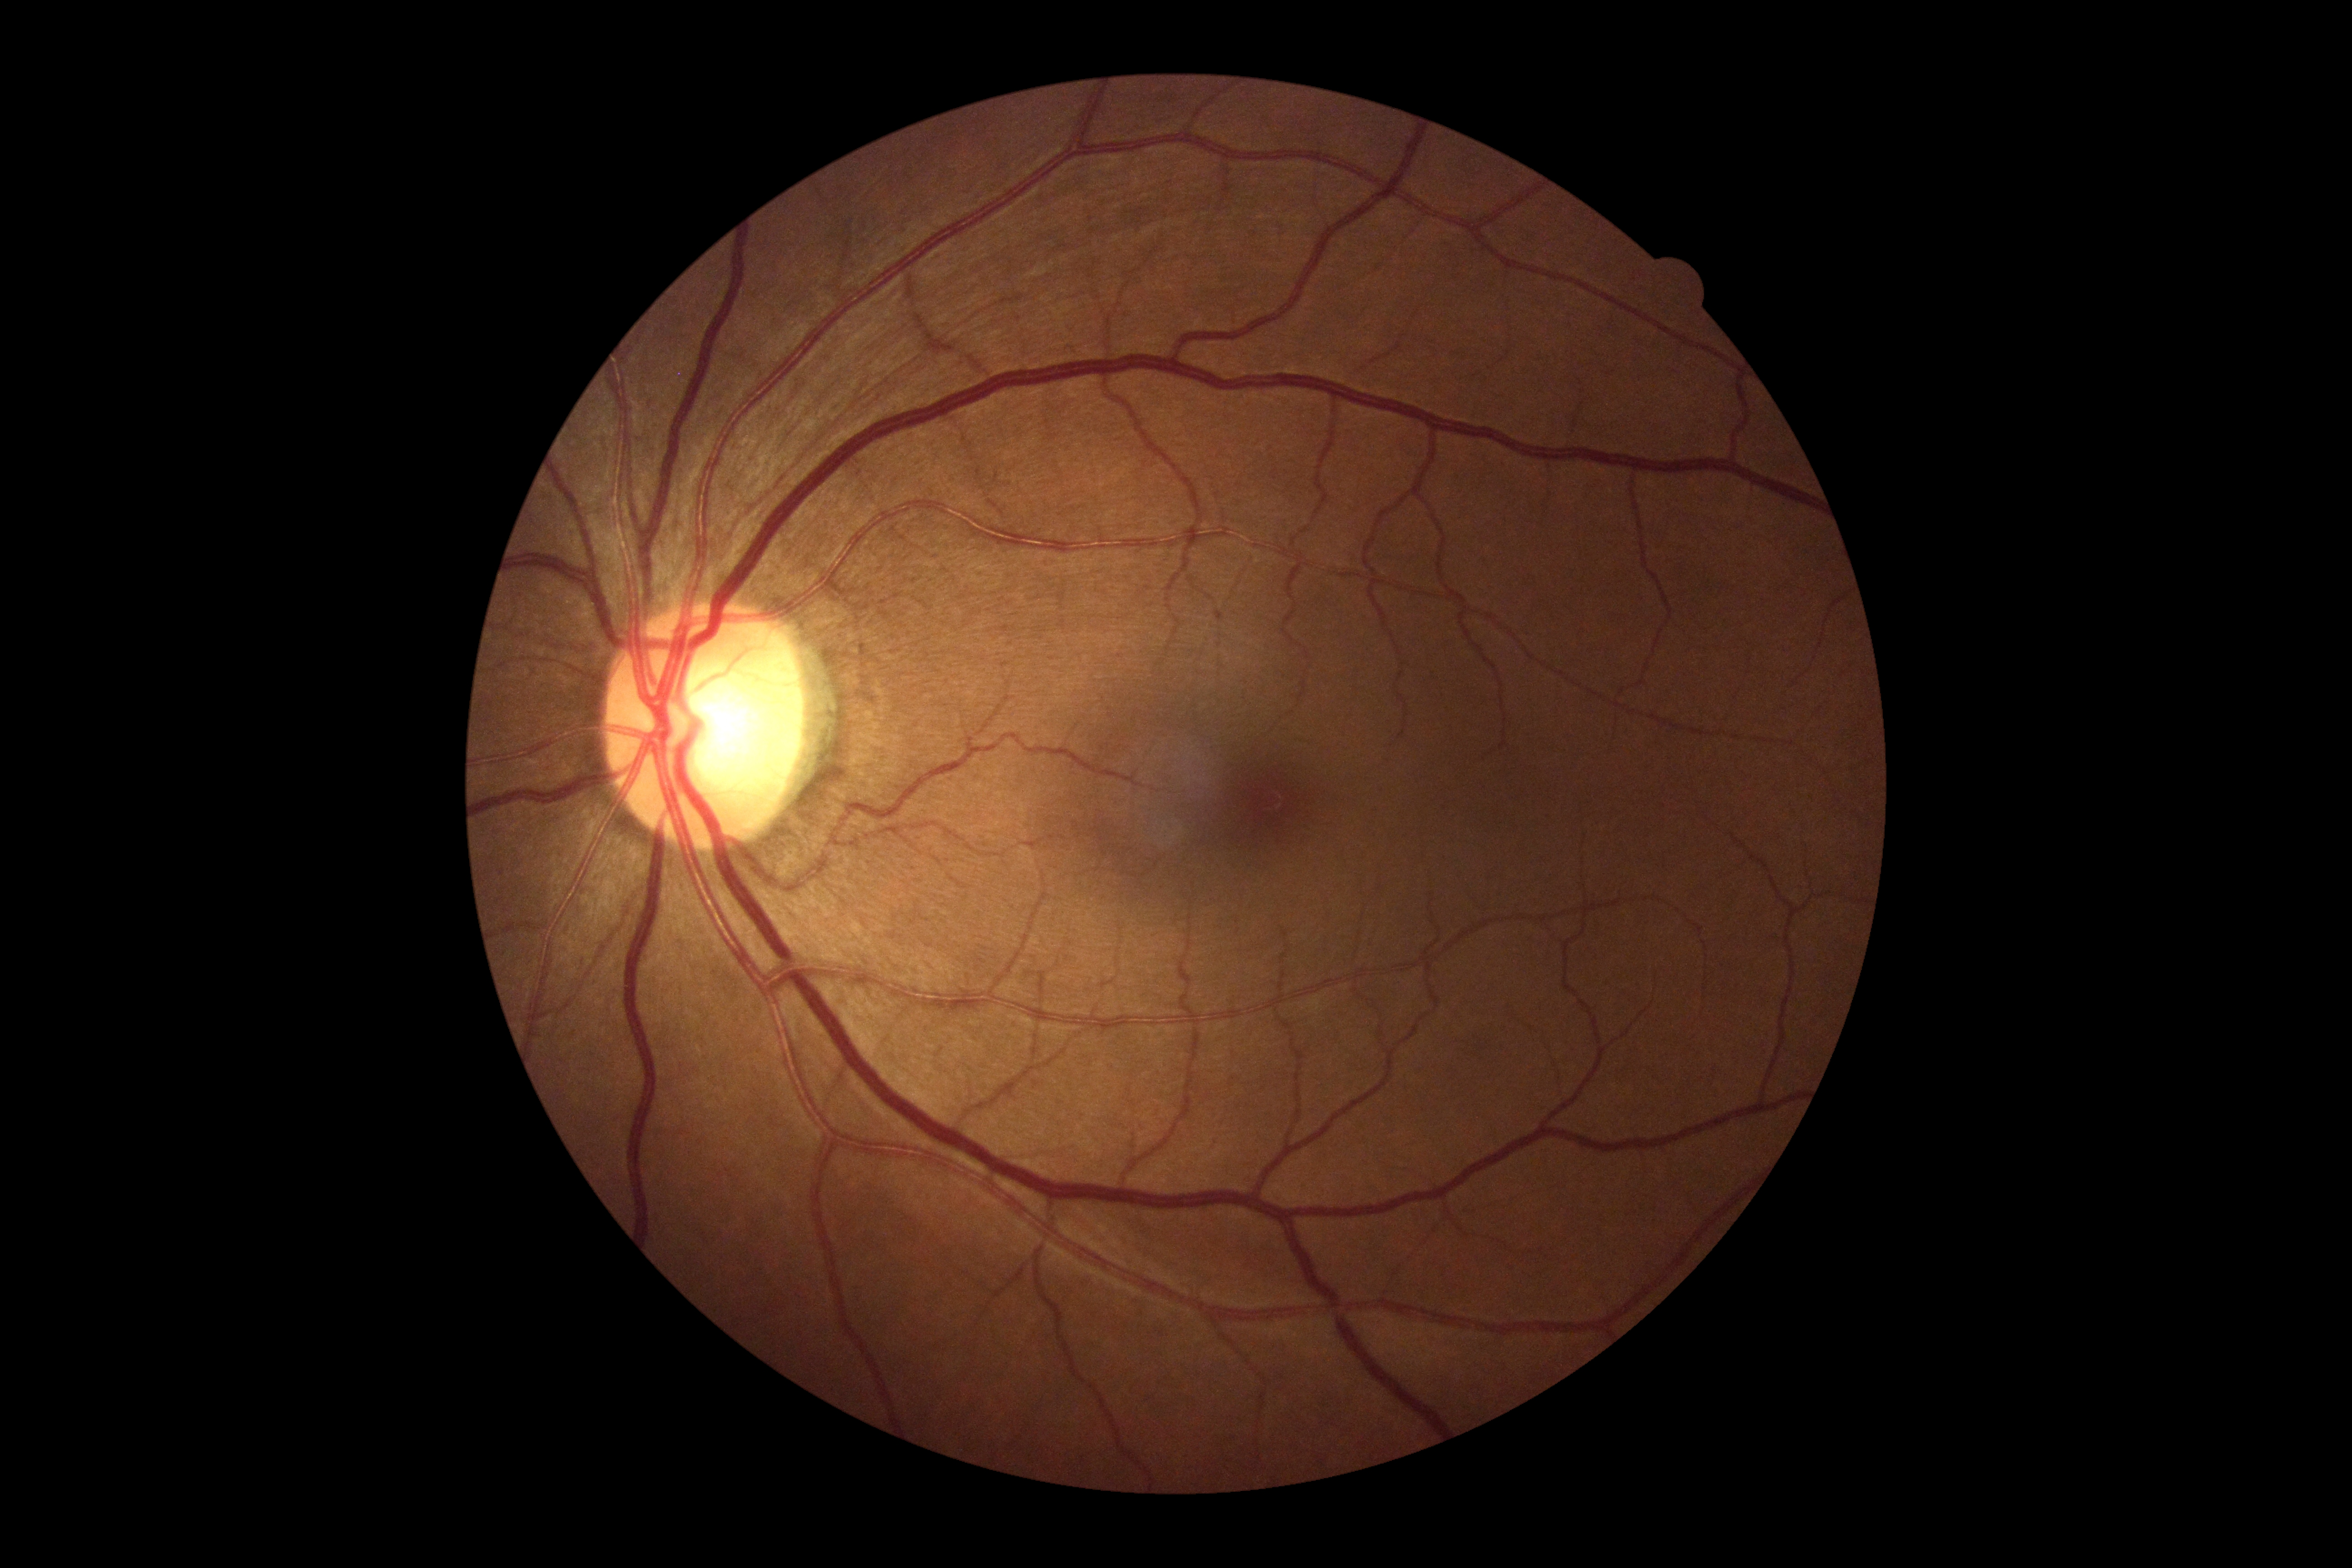
Annotations:
• retinopathy grade — 0
• DR impression — negative for DR